Infant wide-field retinal image — 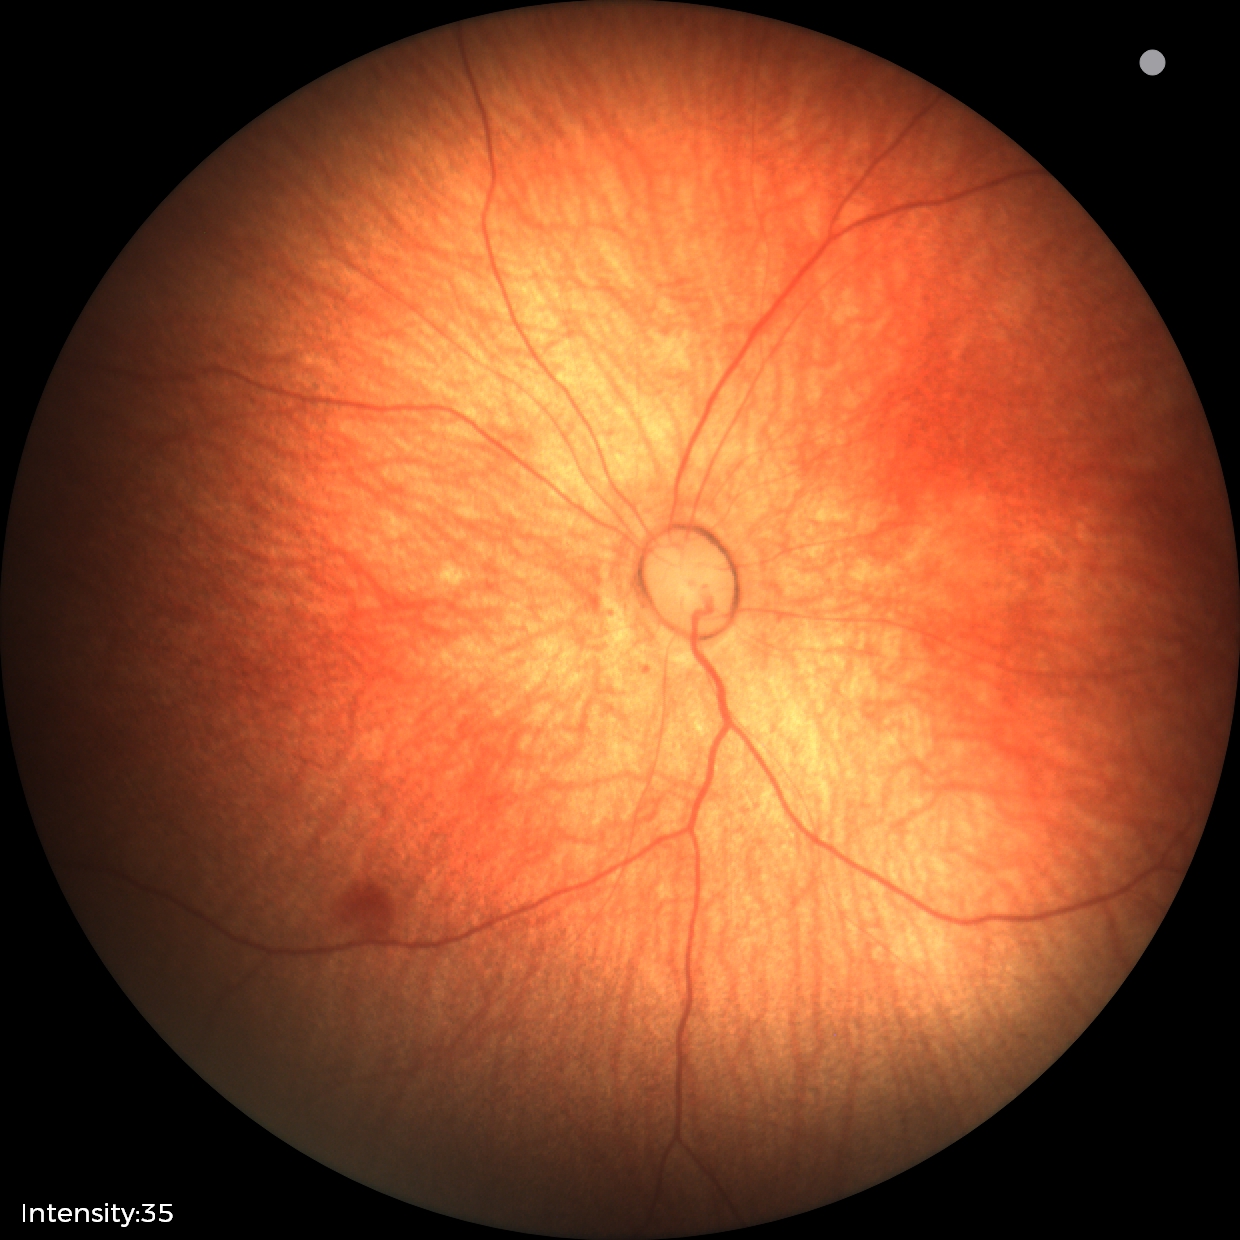
Examination with physiological retinal findings.